45° field of view: 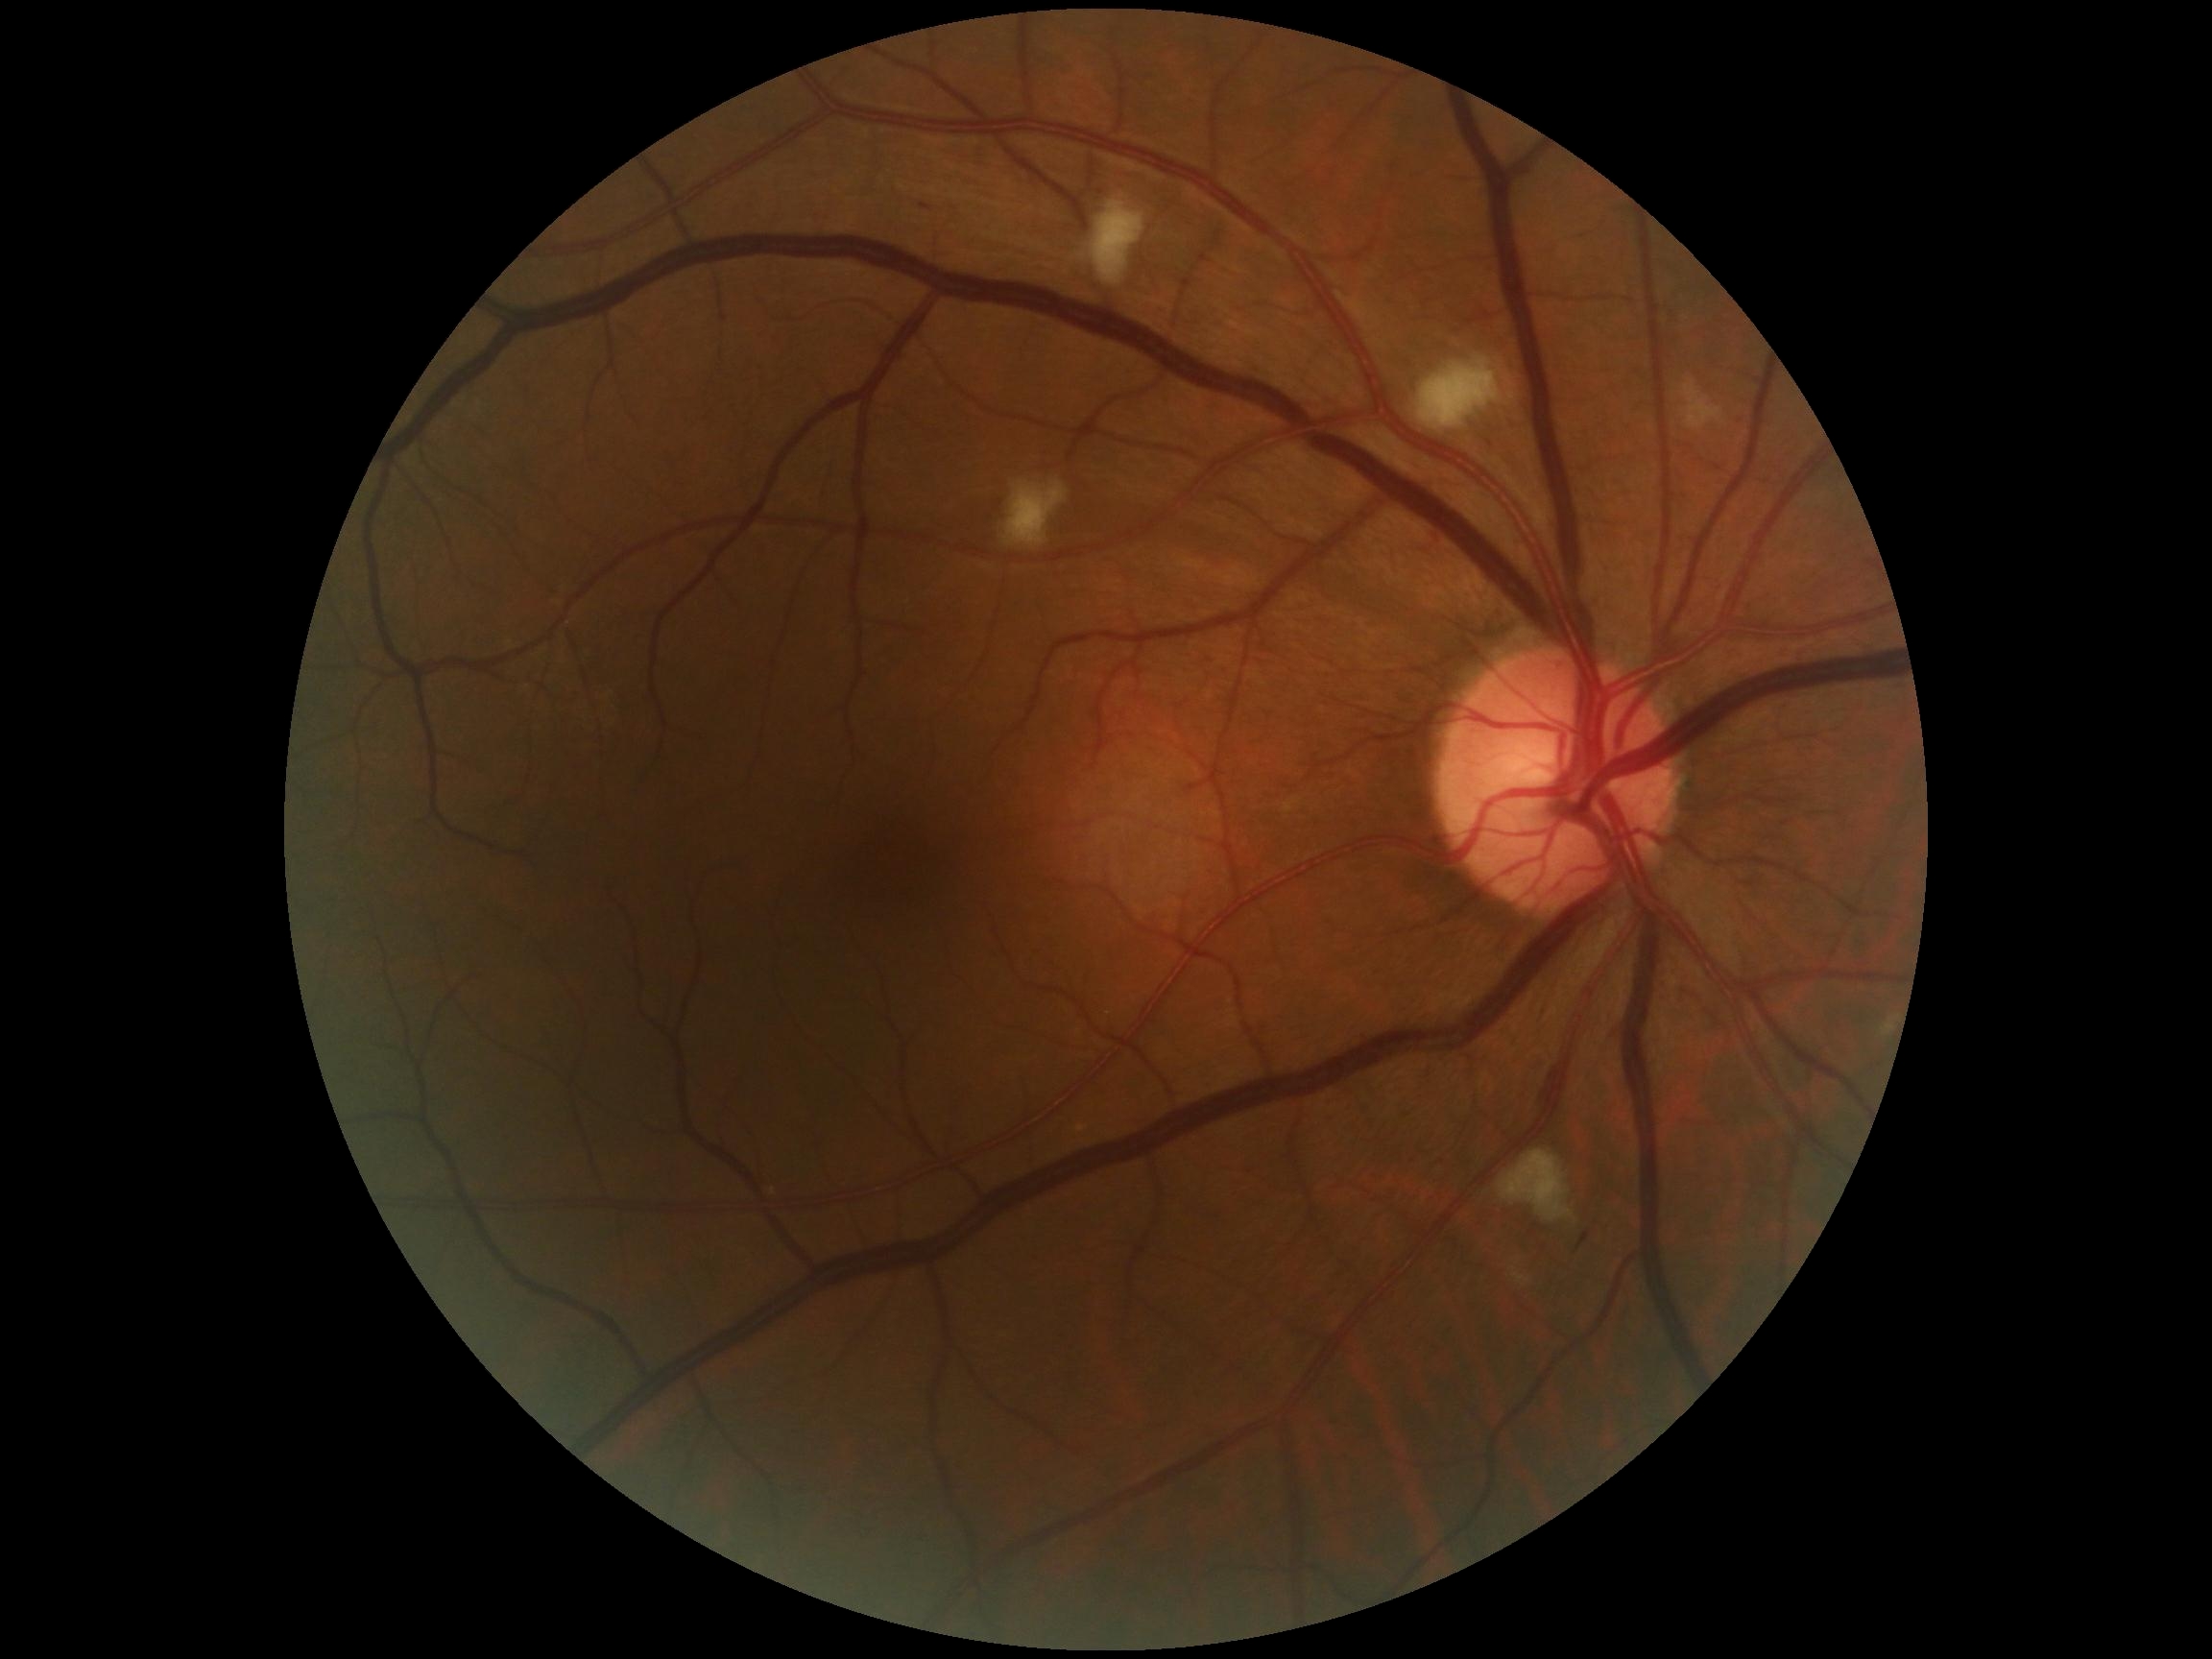
DR: moderate NPDR (grade 2) — more than just microaneurysms but less than severe NPDR.